1440x1080. Infant wide-field fundus photograph — 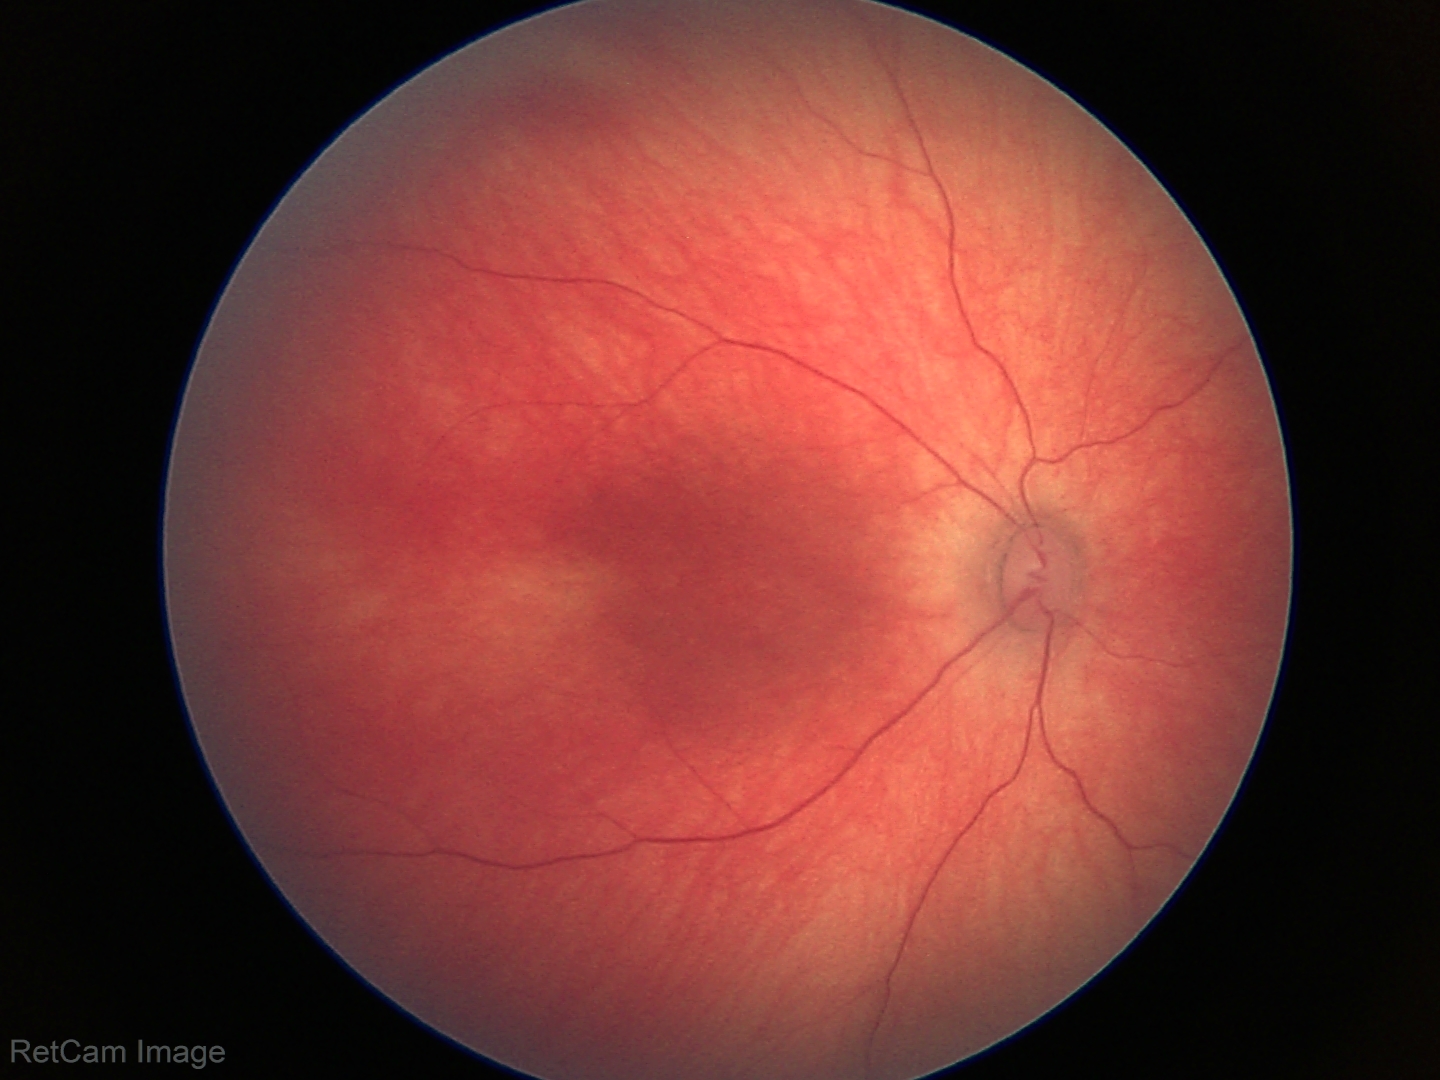
Examination with physiological retinal findings.